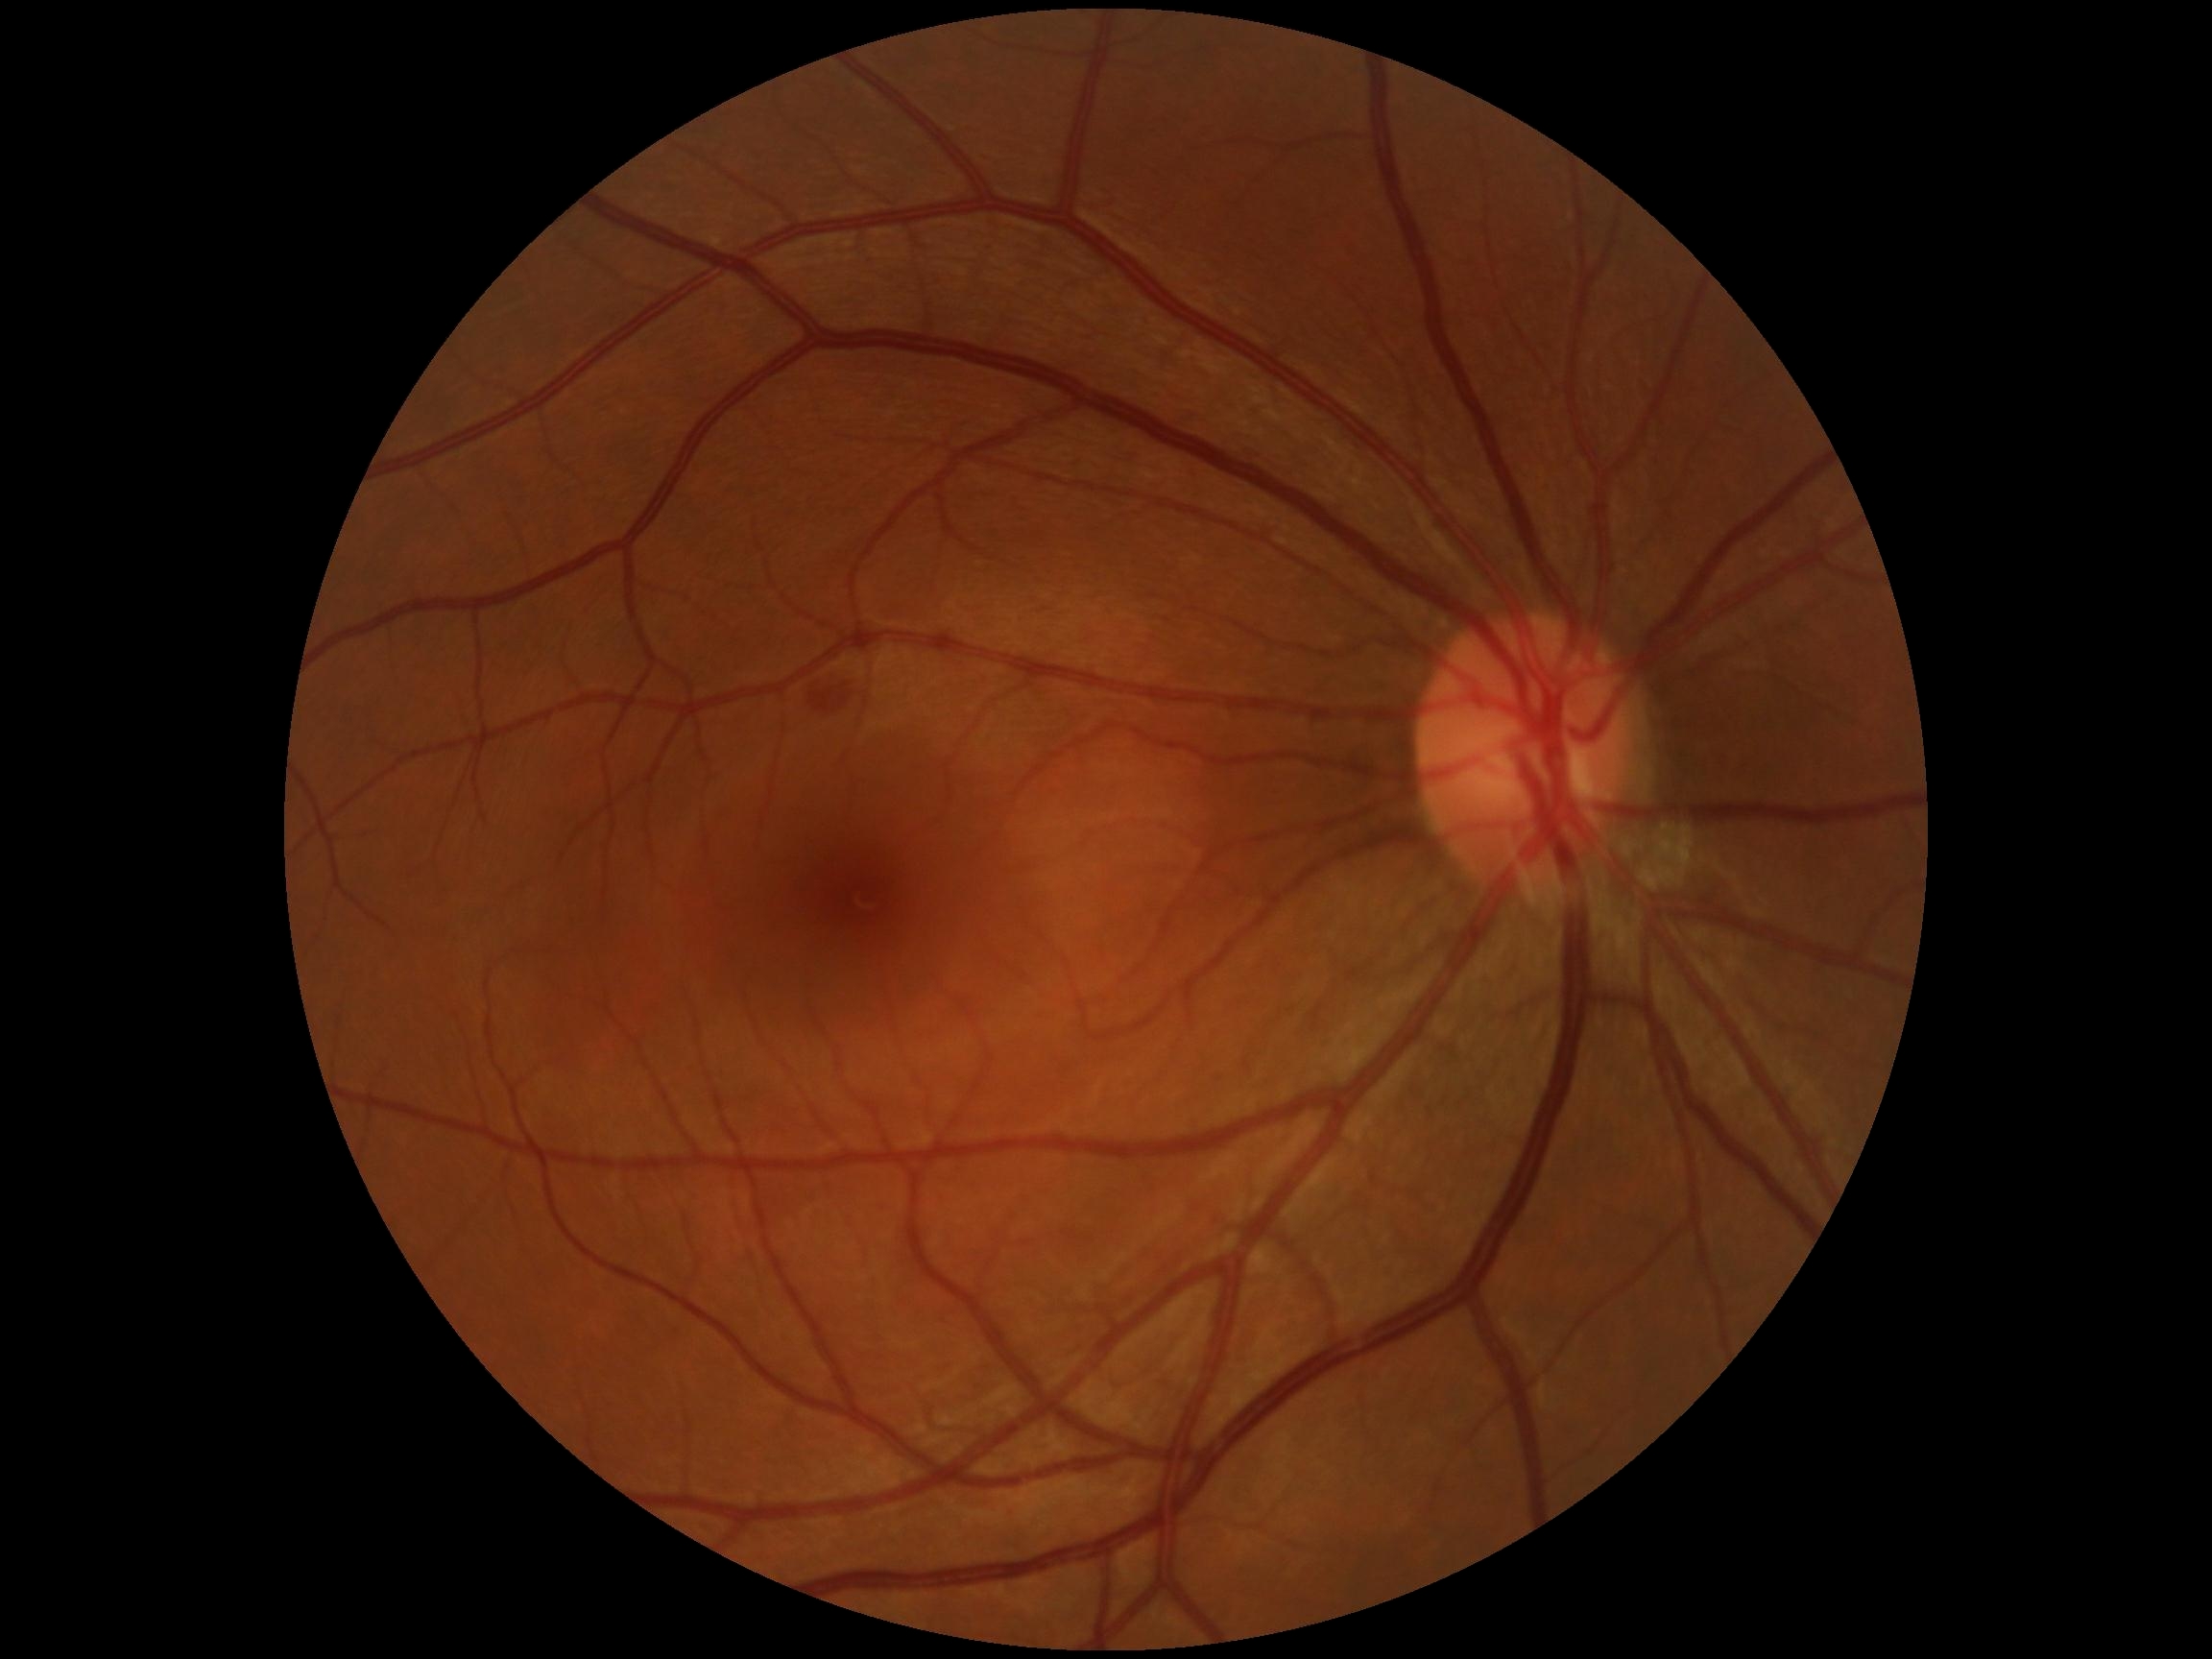
DR severity: 2.